45-degree field of view · CFP — 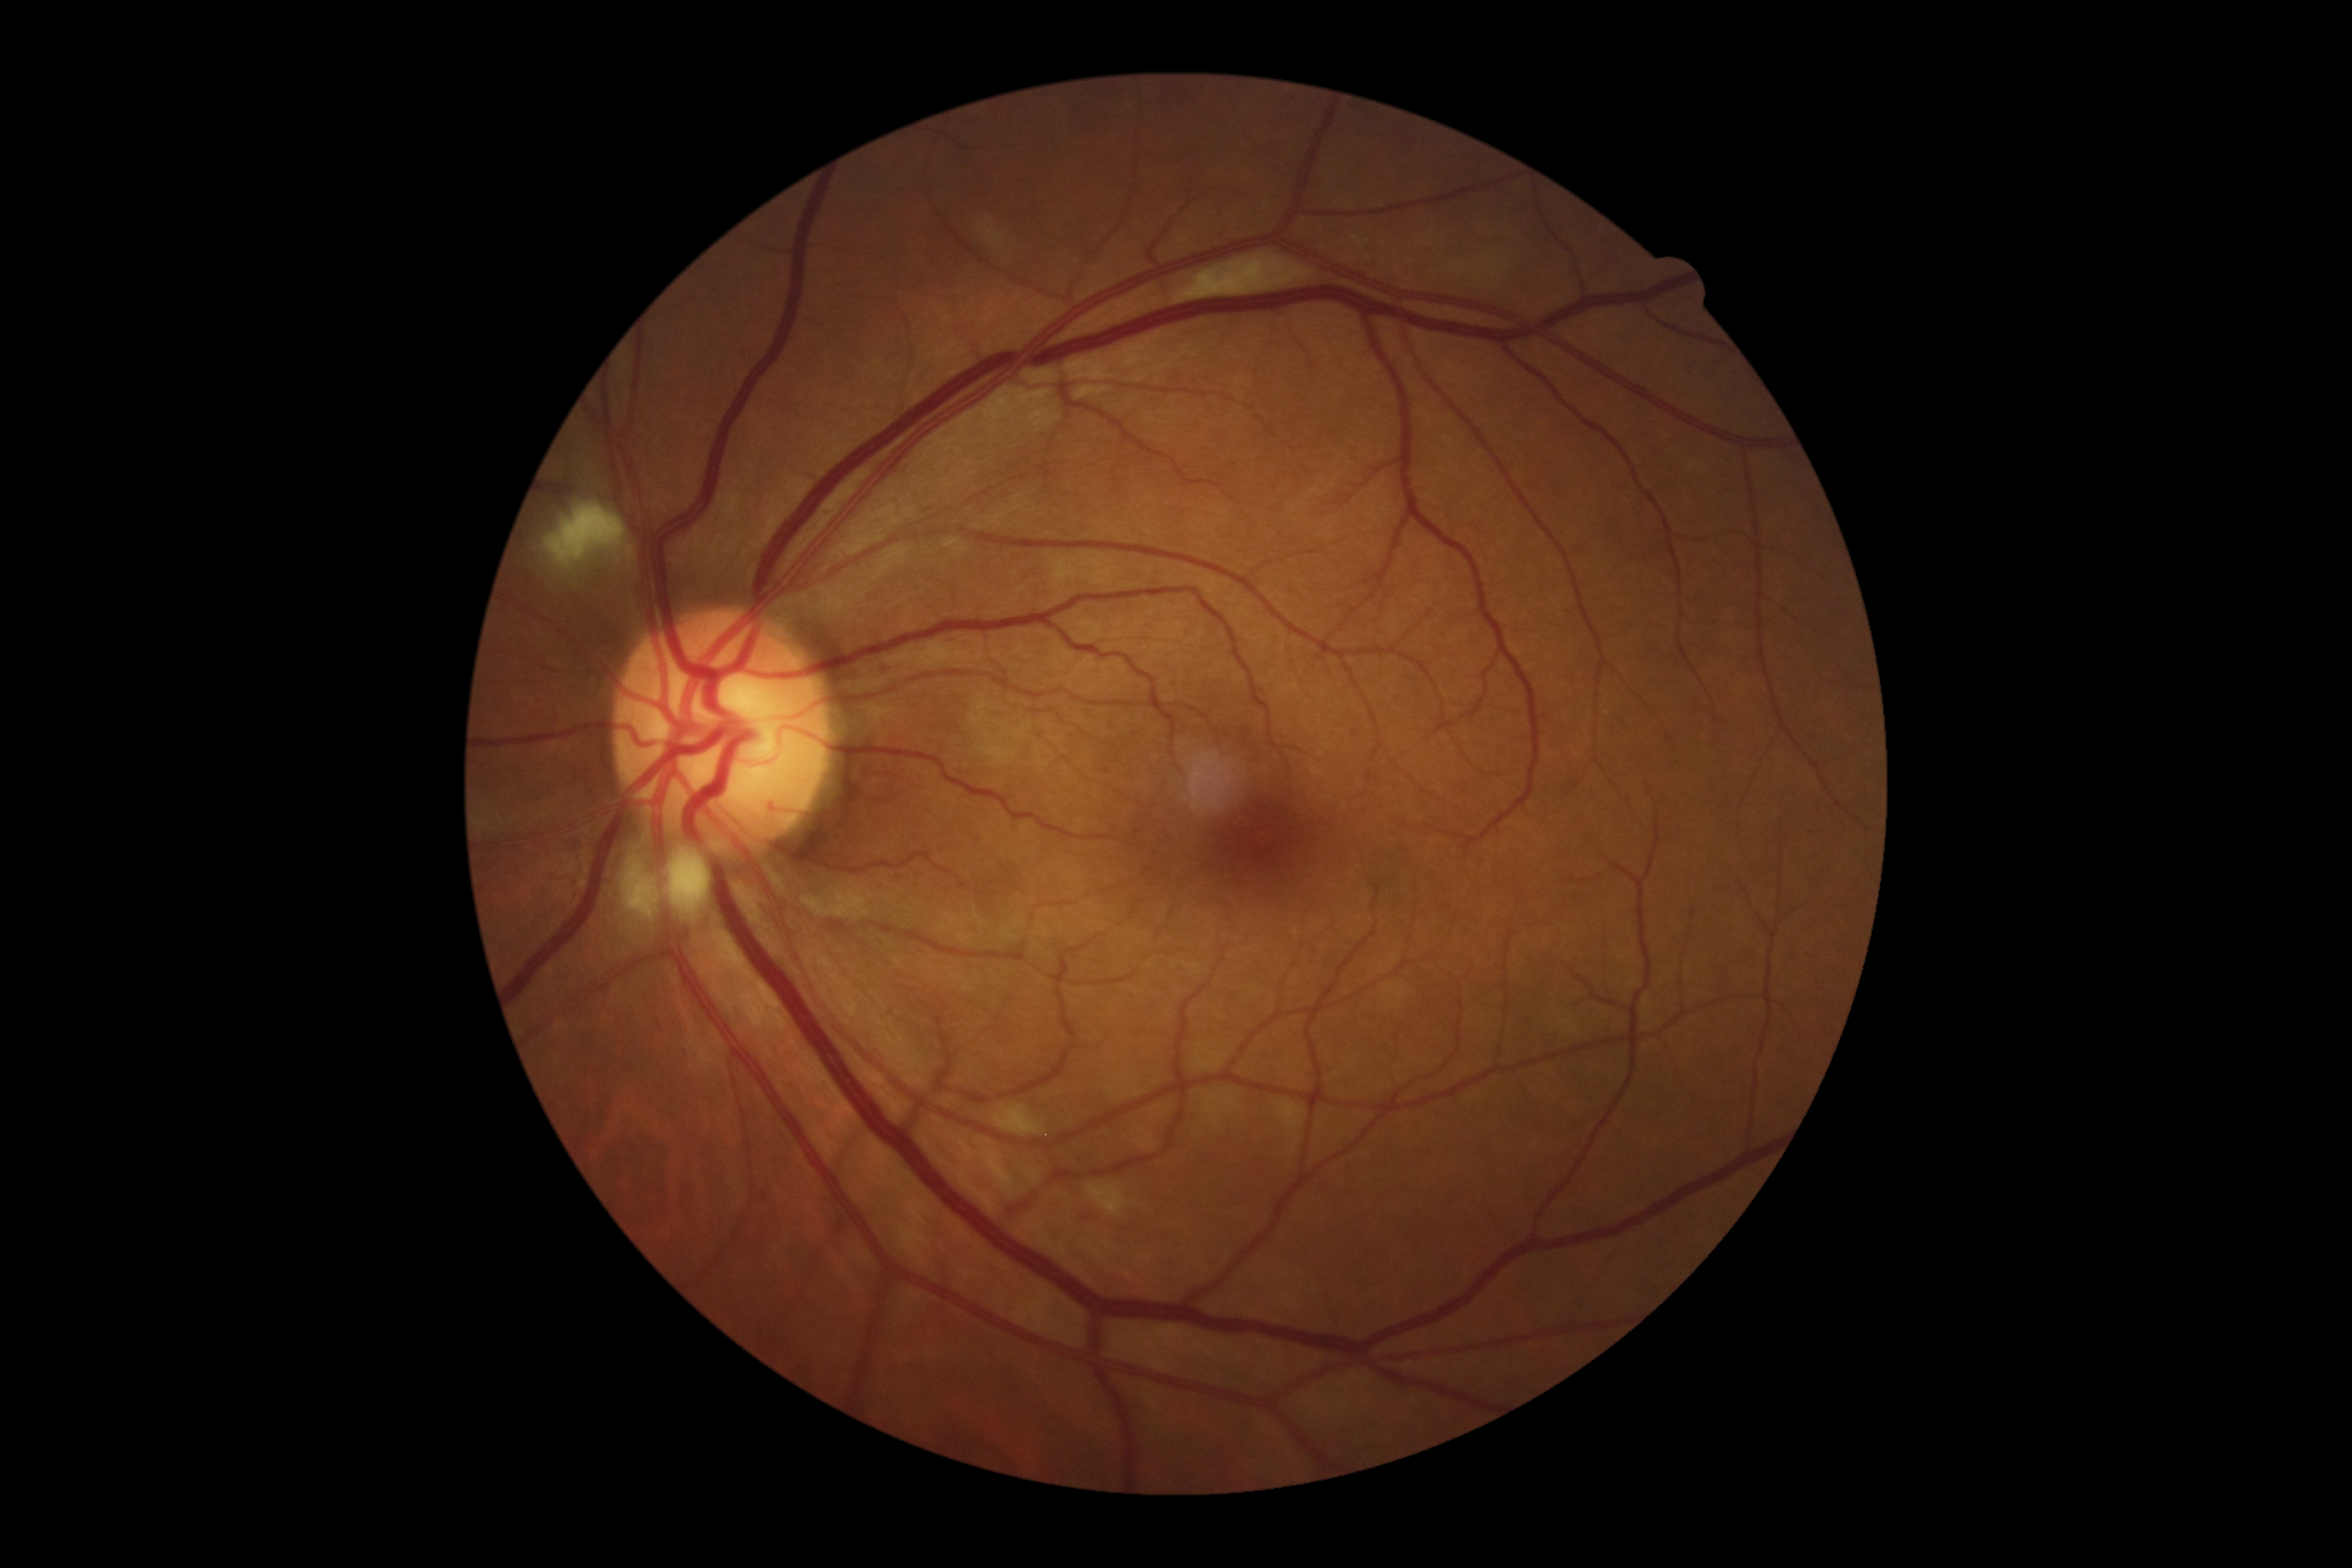 DR class@non-proliferative diabetic retinopathy; diabetic retinopathy (DR)@2.